848x848px · 45 degree fundus photograph · fundus photo · NIDEK AFC-230 fundus camera:
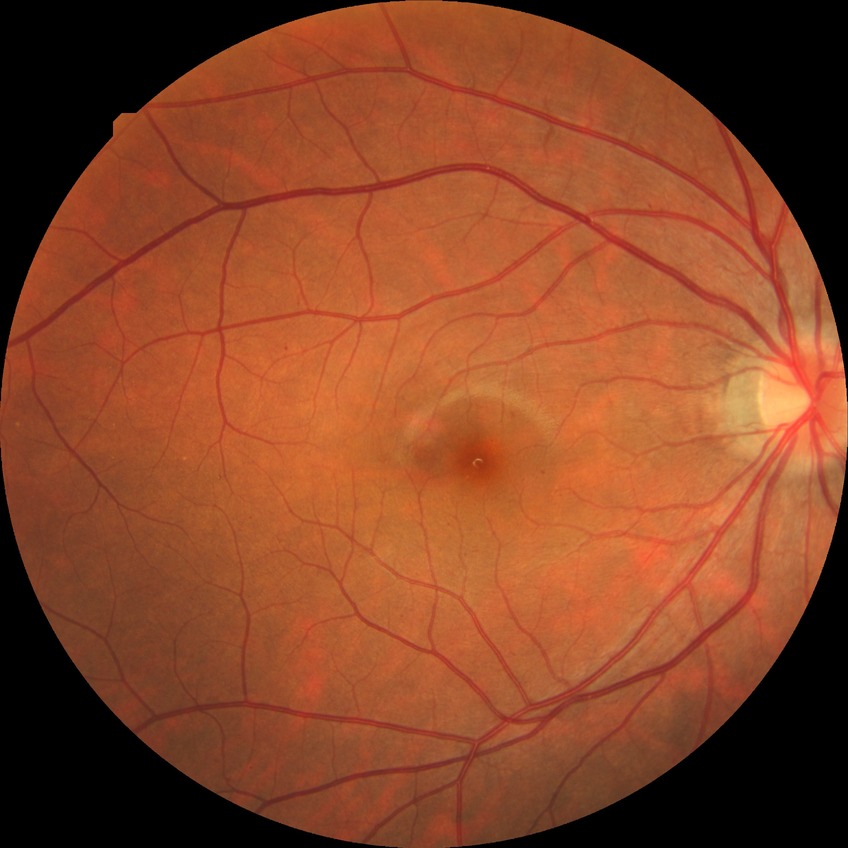 DR stage = SDR